Nidek AFC-330. Non-mydriatic fundus camera. Disc-centered field
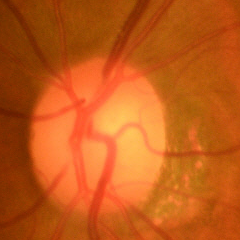 Q: Is glaucoma present?
A: Early glaucomatous changes.